Fundus photo; 1470x1137px — 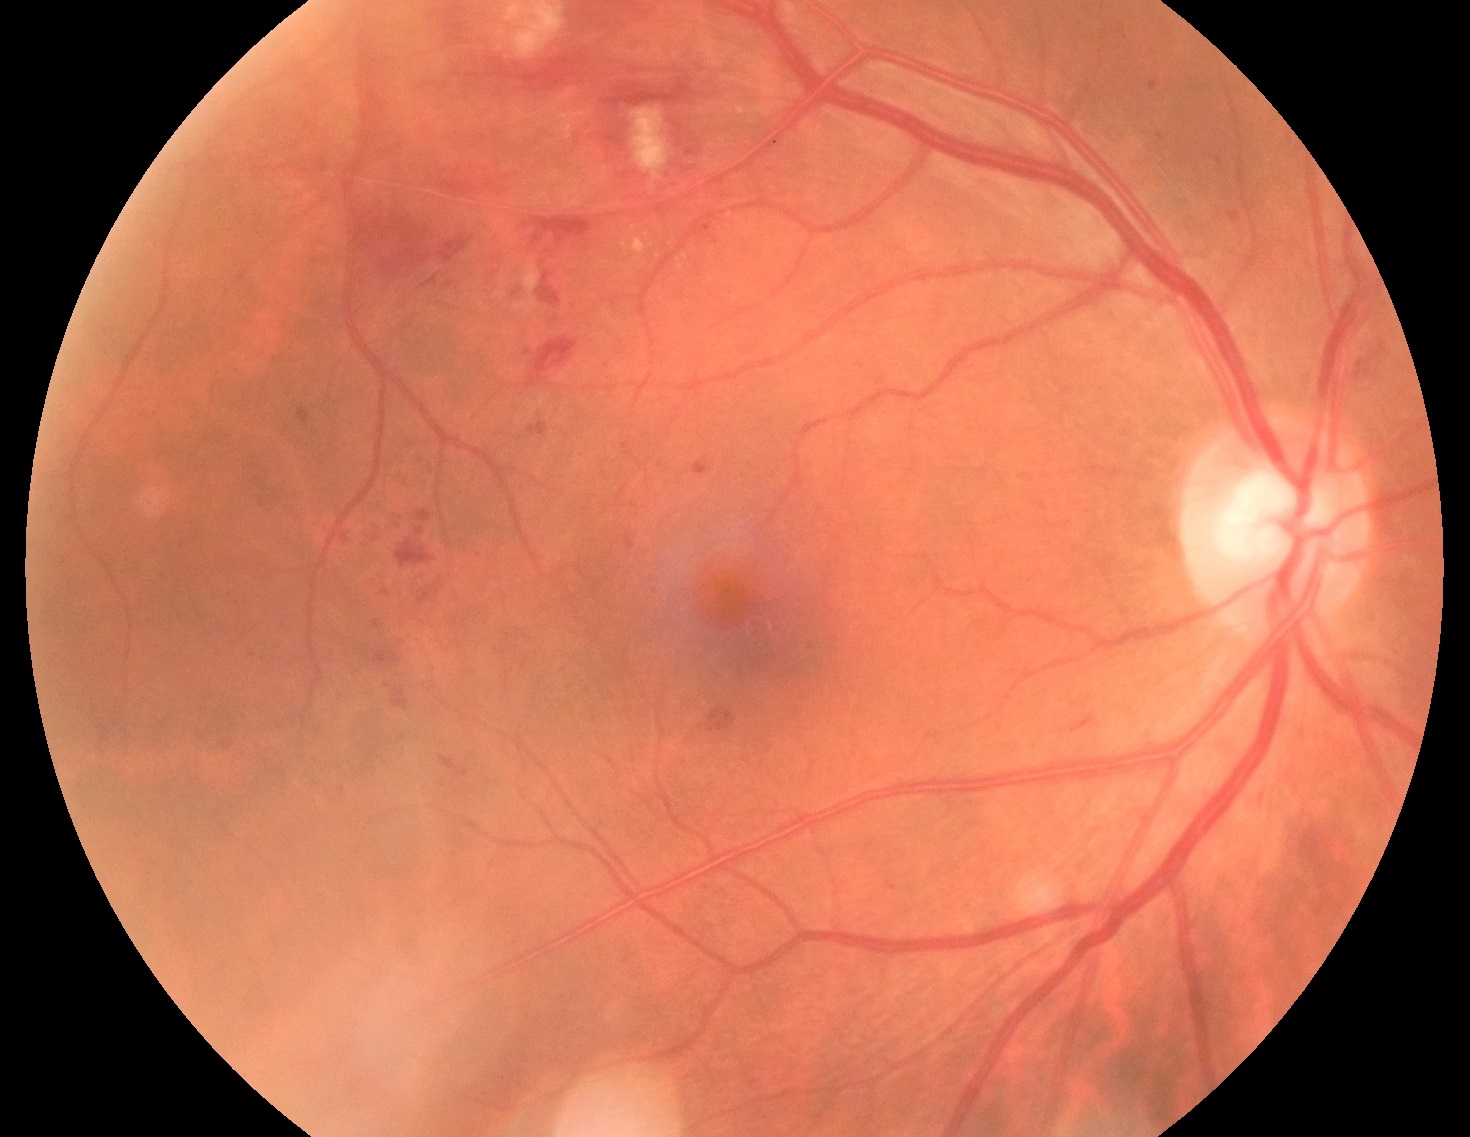 Annotations:
- diabetic retinopathy — 2